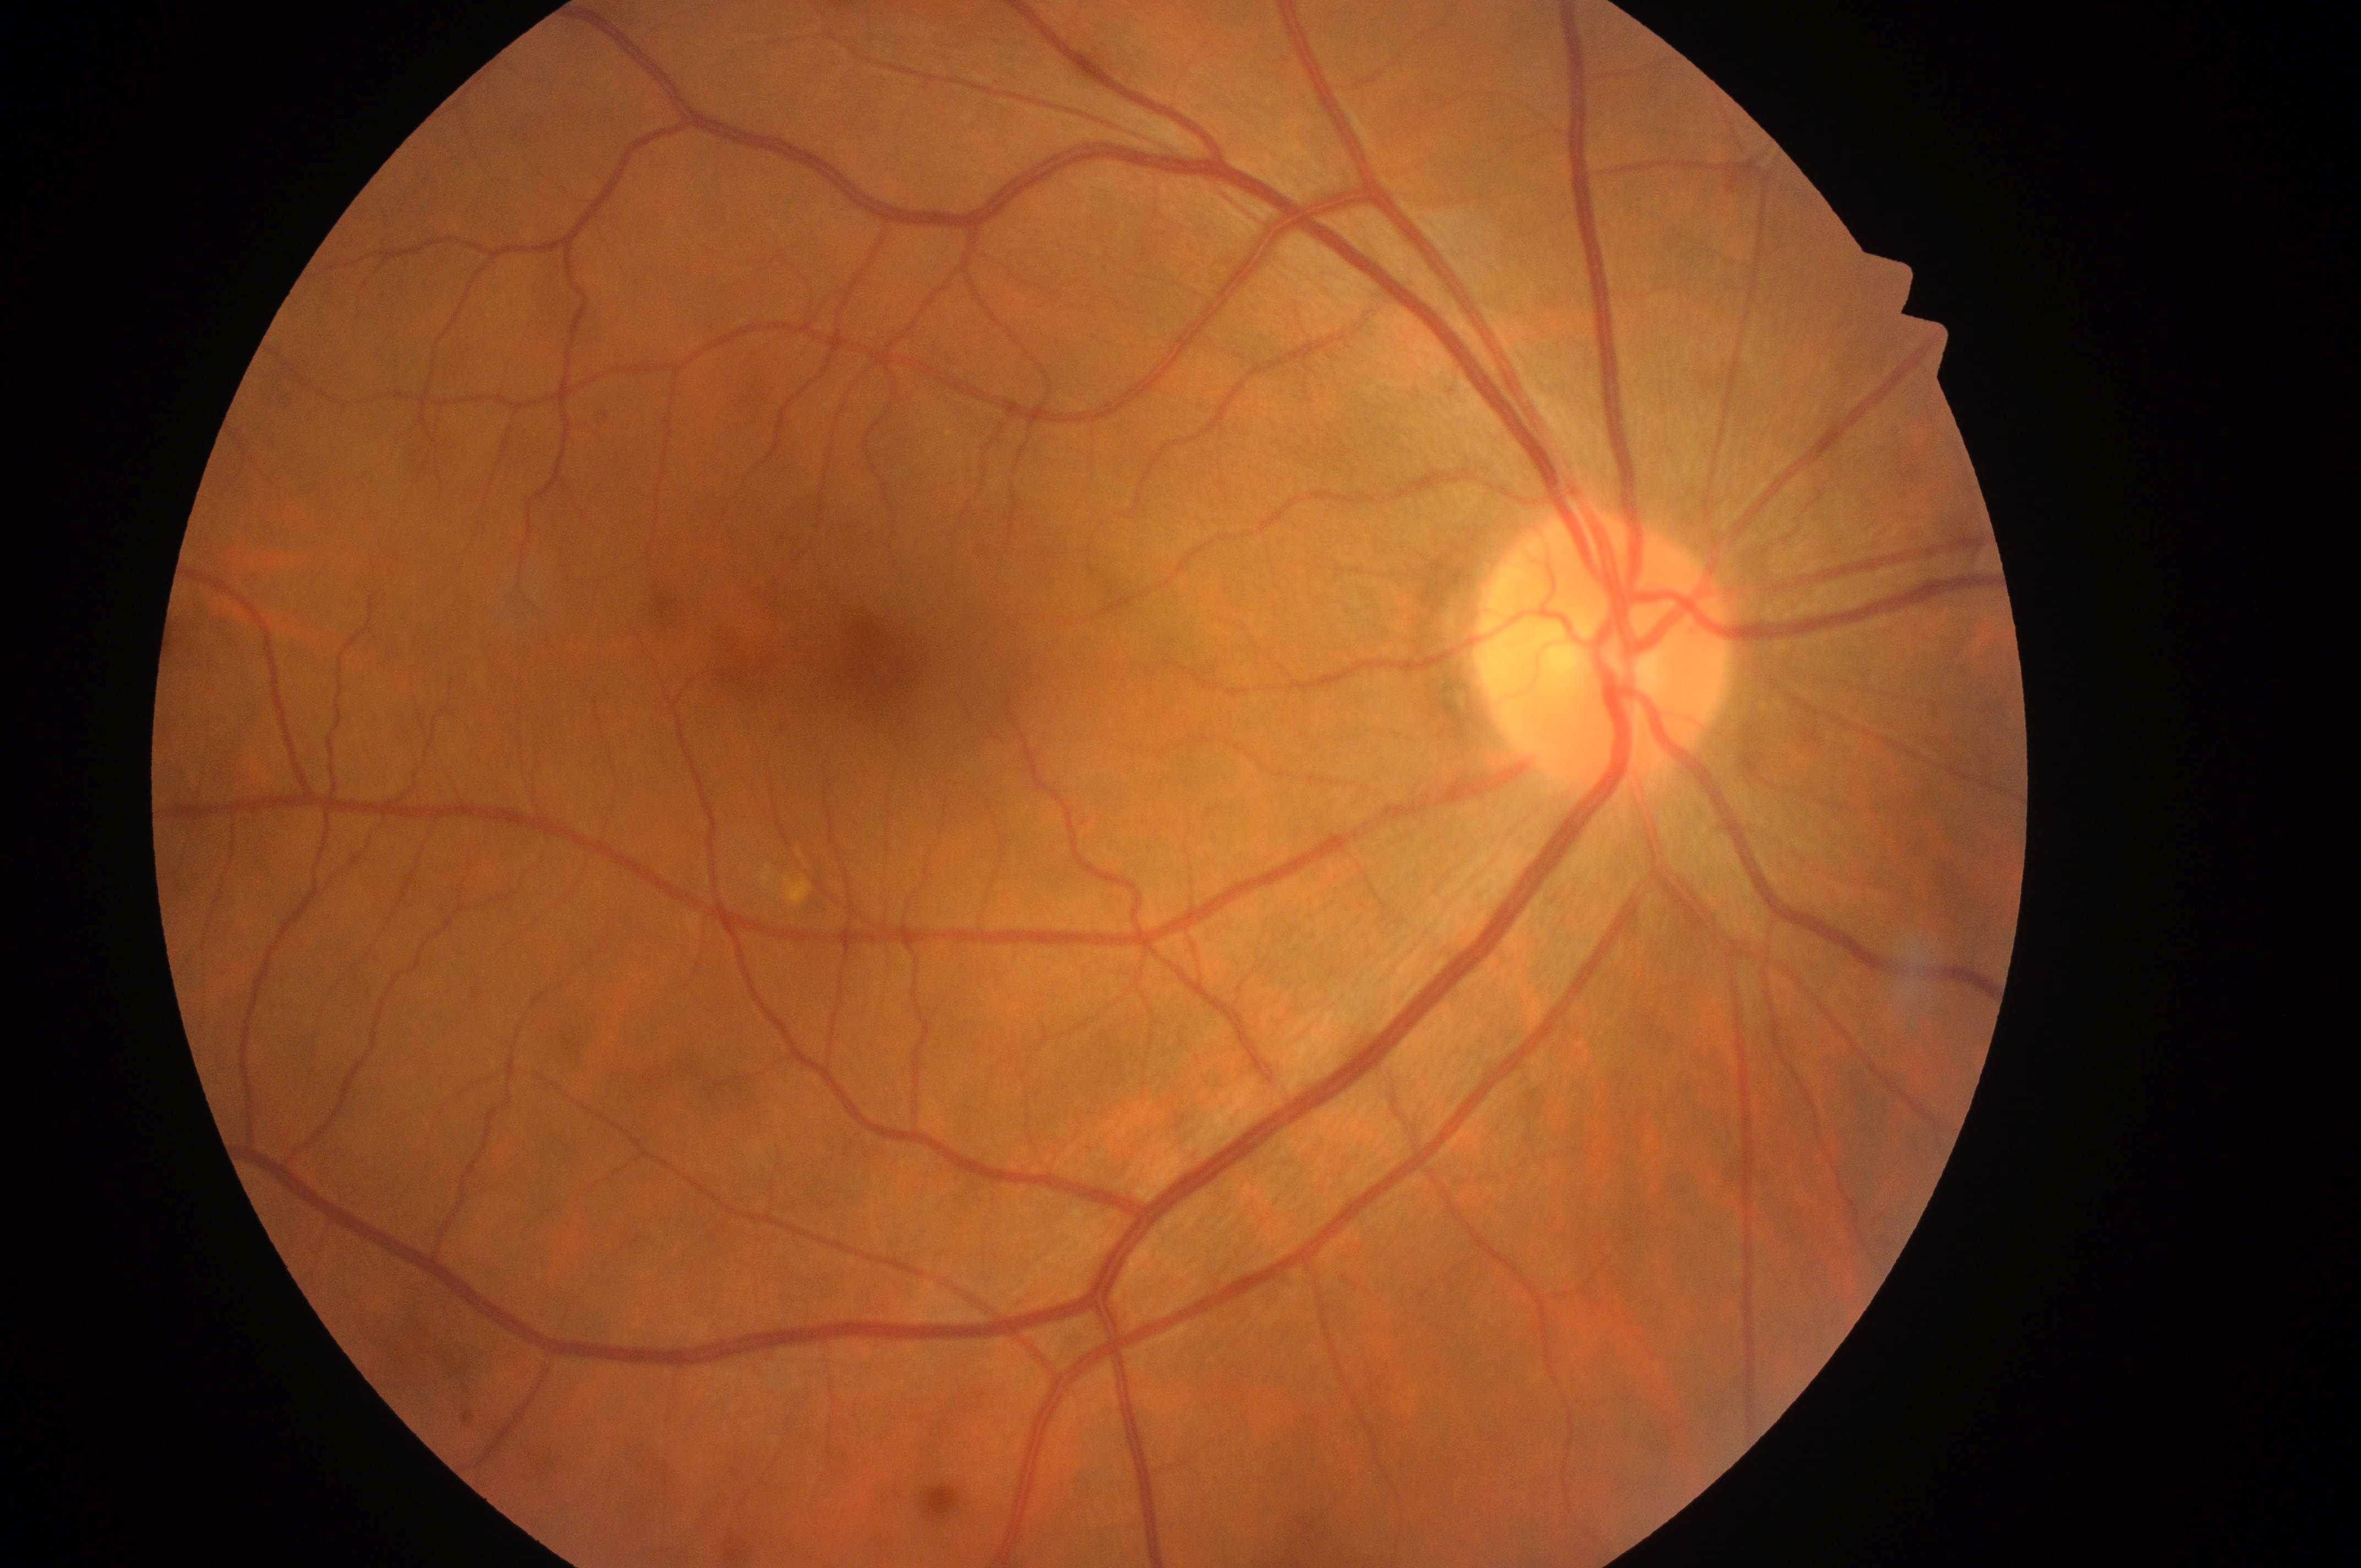
DME: no risk (grade 0). The optic disc is at (x: 1601, y: 657). DR grade: no apparent retinopathy (0). Imaged eye: the right eye. Fovea centralis: (x: 879, y: 668). No apparent diabetic retinopathy or macular edema.